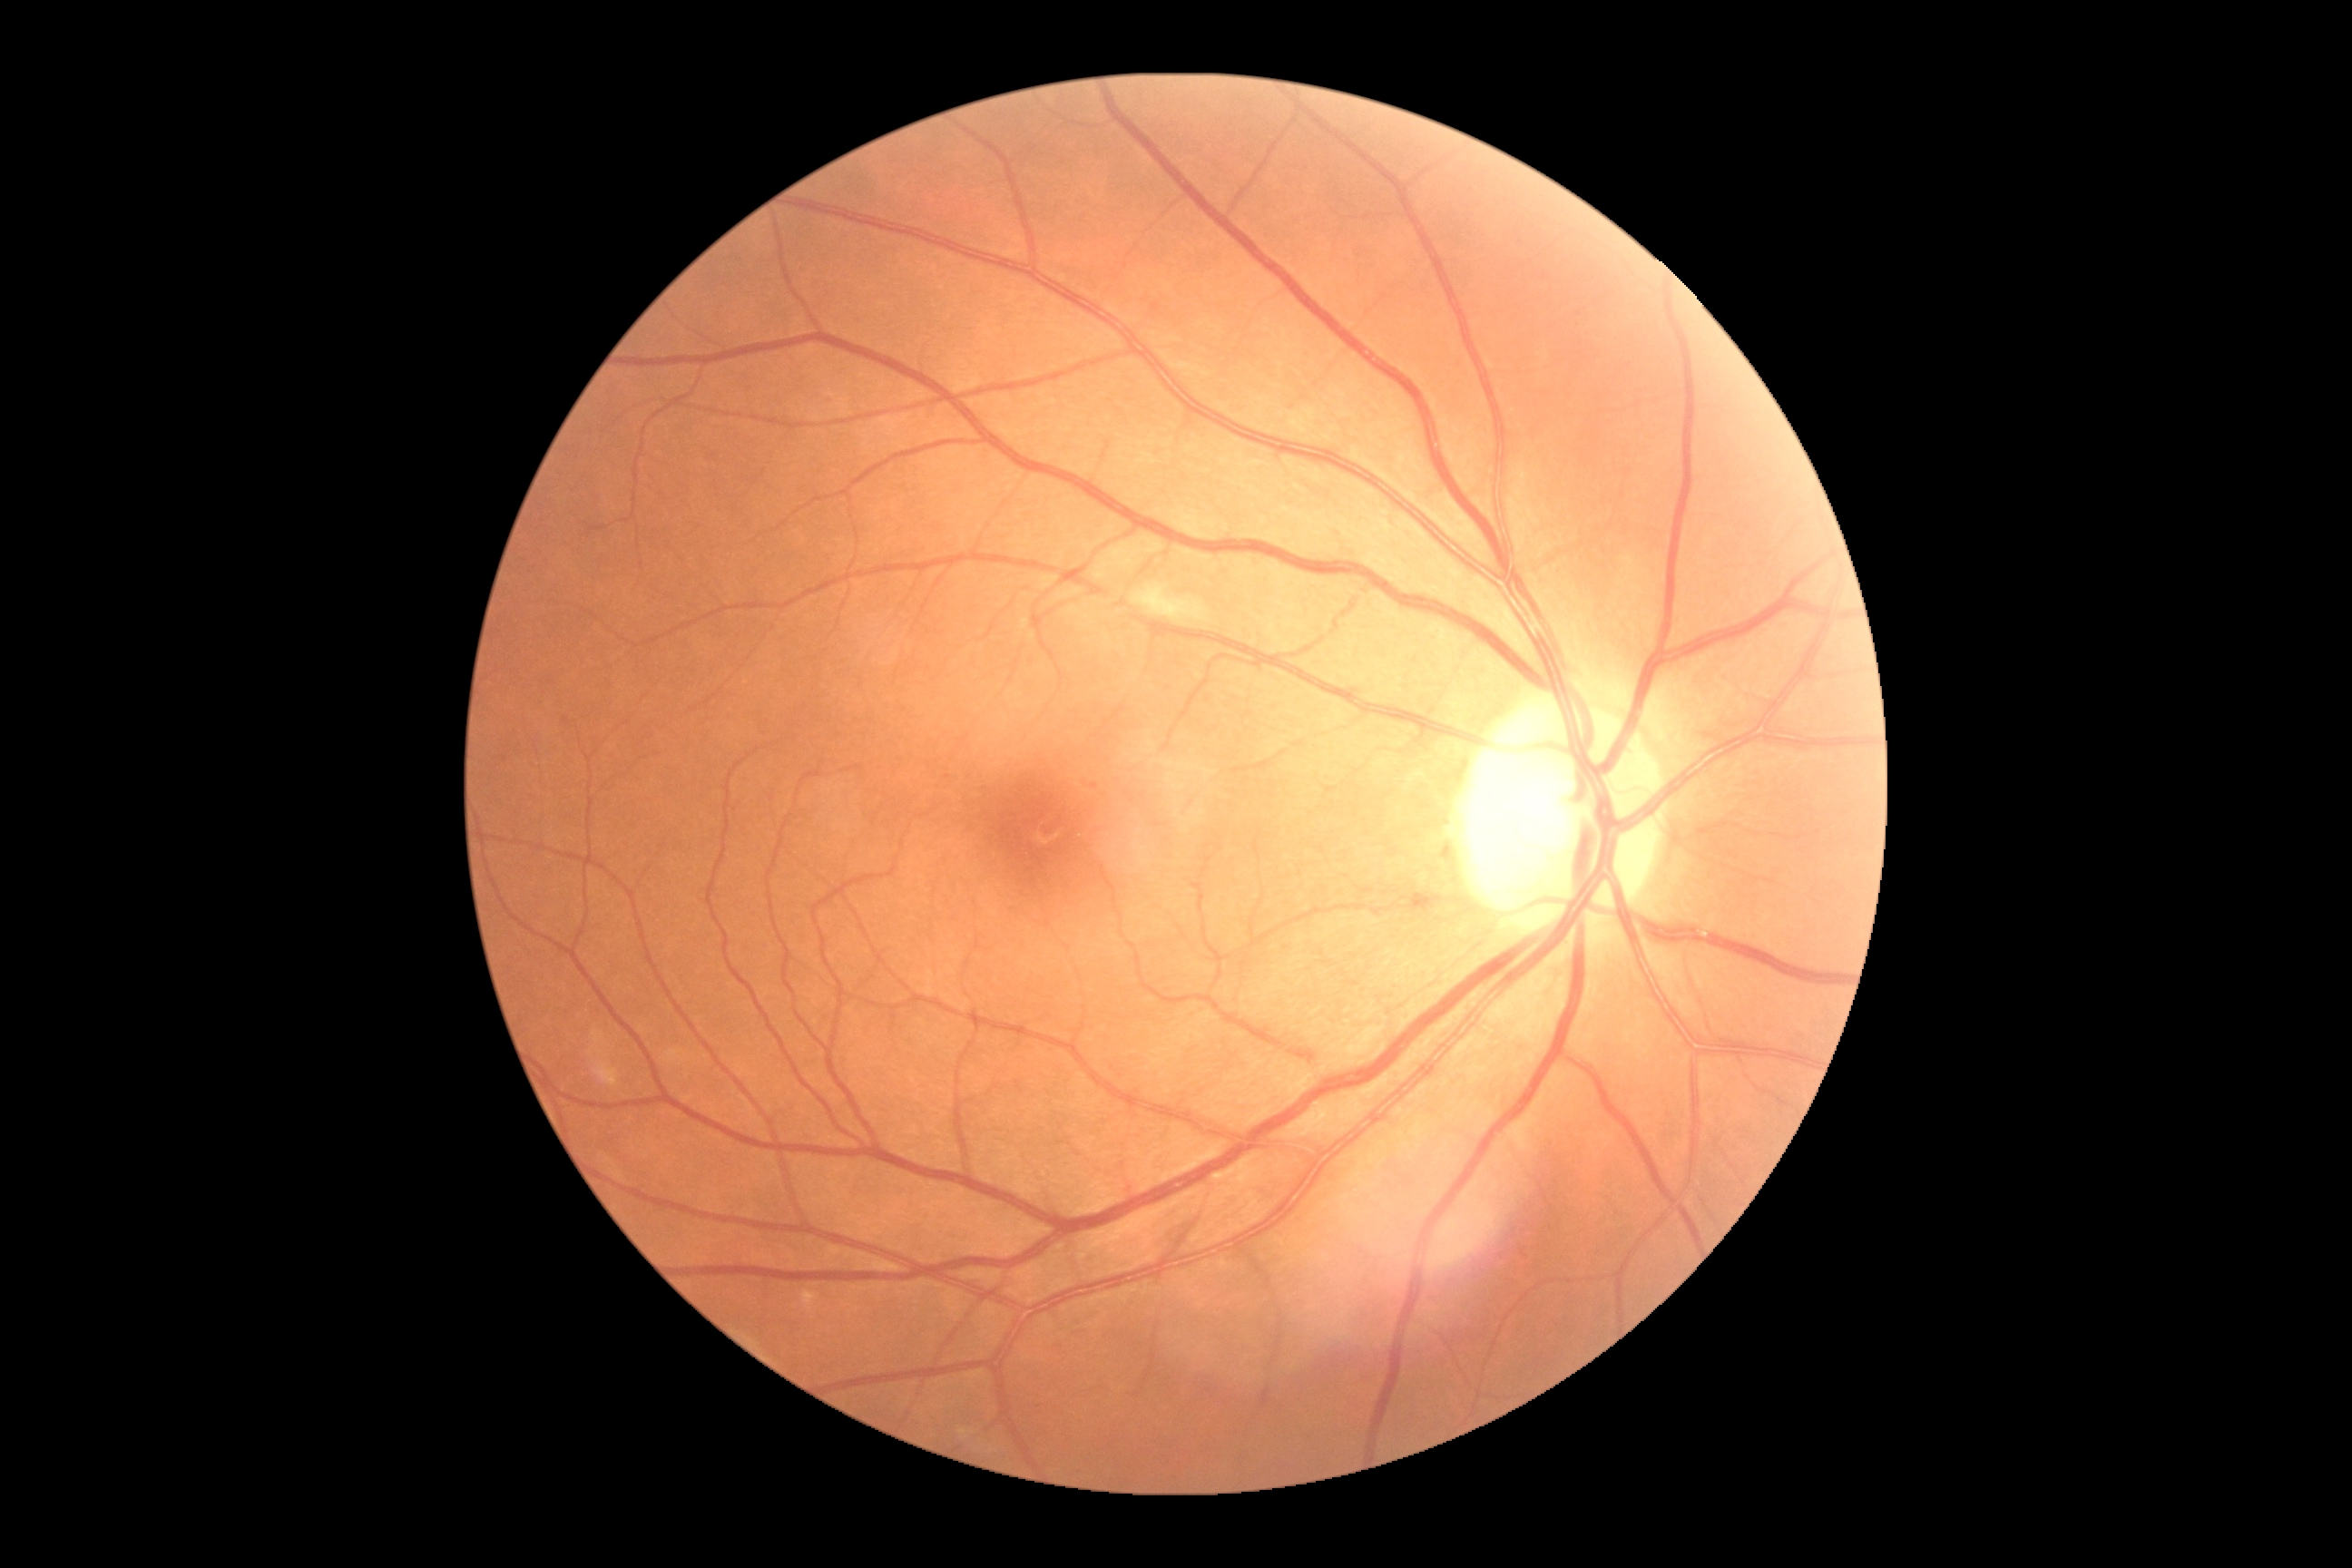
Diabetic retinopathy (DR) is 2/4.